848 by 848 pixels:
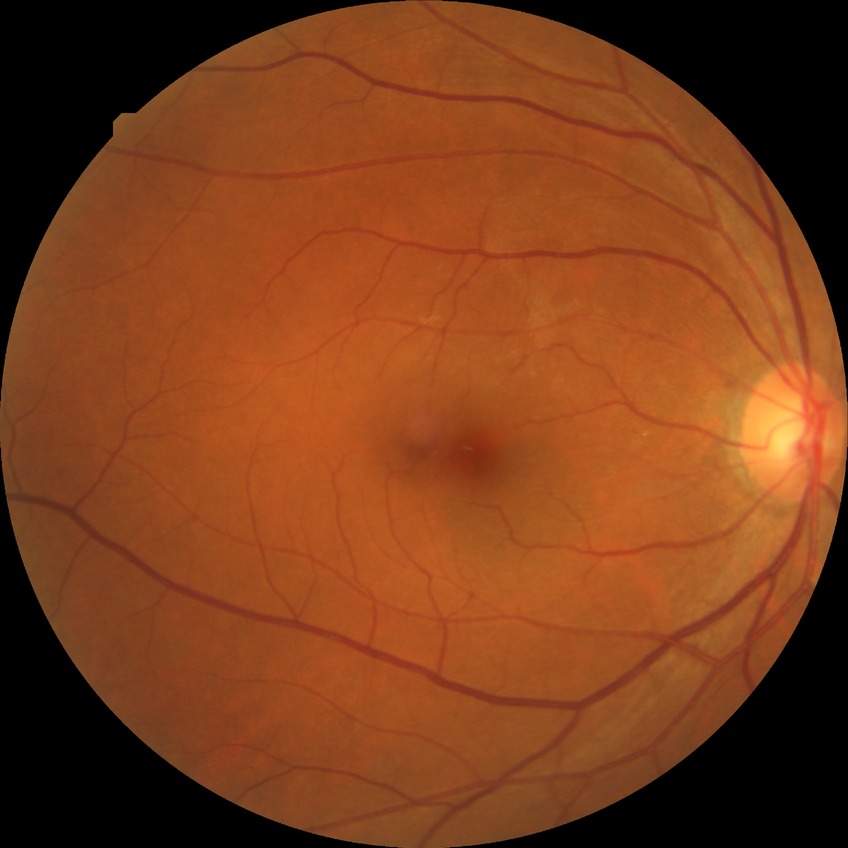 diabetic retinopathy (DR): no diabetic retinopathy (NDR)